Acquired with a NIDEK AFC-230; 848x848.
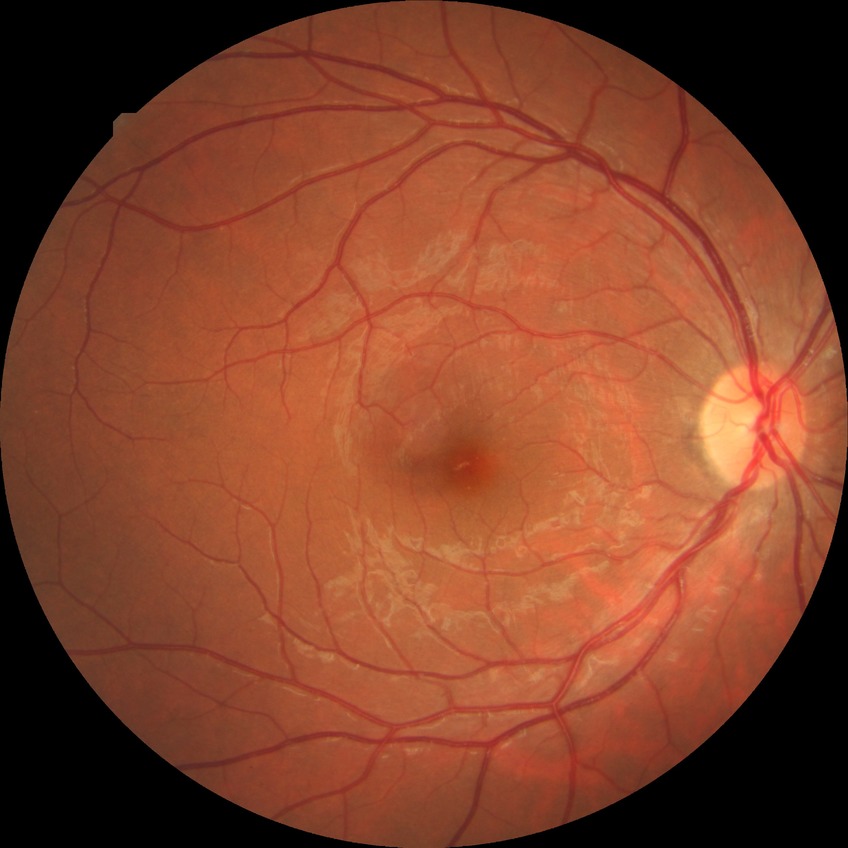
Diabetic retinopathy severity is no diabetic retinopathy.